848x848, 45-degree field of view, posterior pole color fundus photograph, camera: NIDEK AFC-230, nonmydriatic
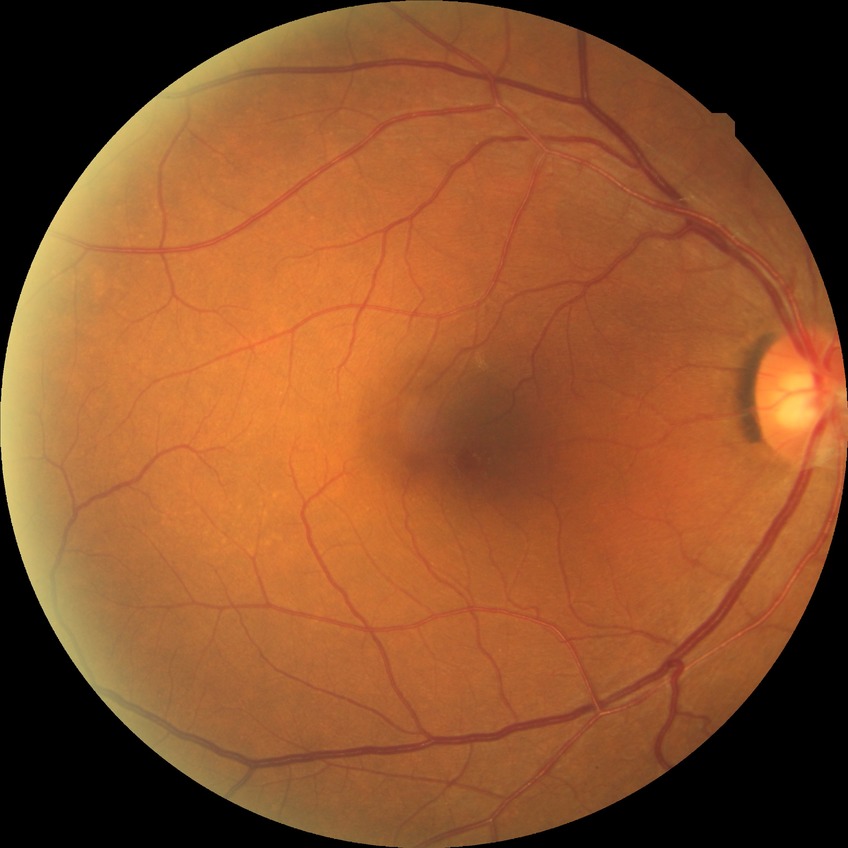 Diabetic retinopathy severity is no diabetic retinopathy.